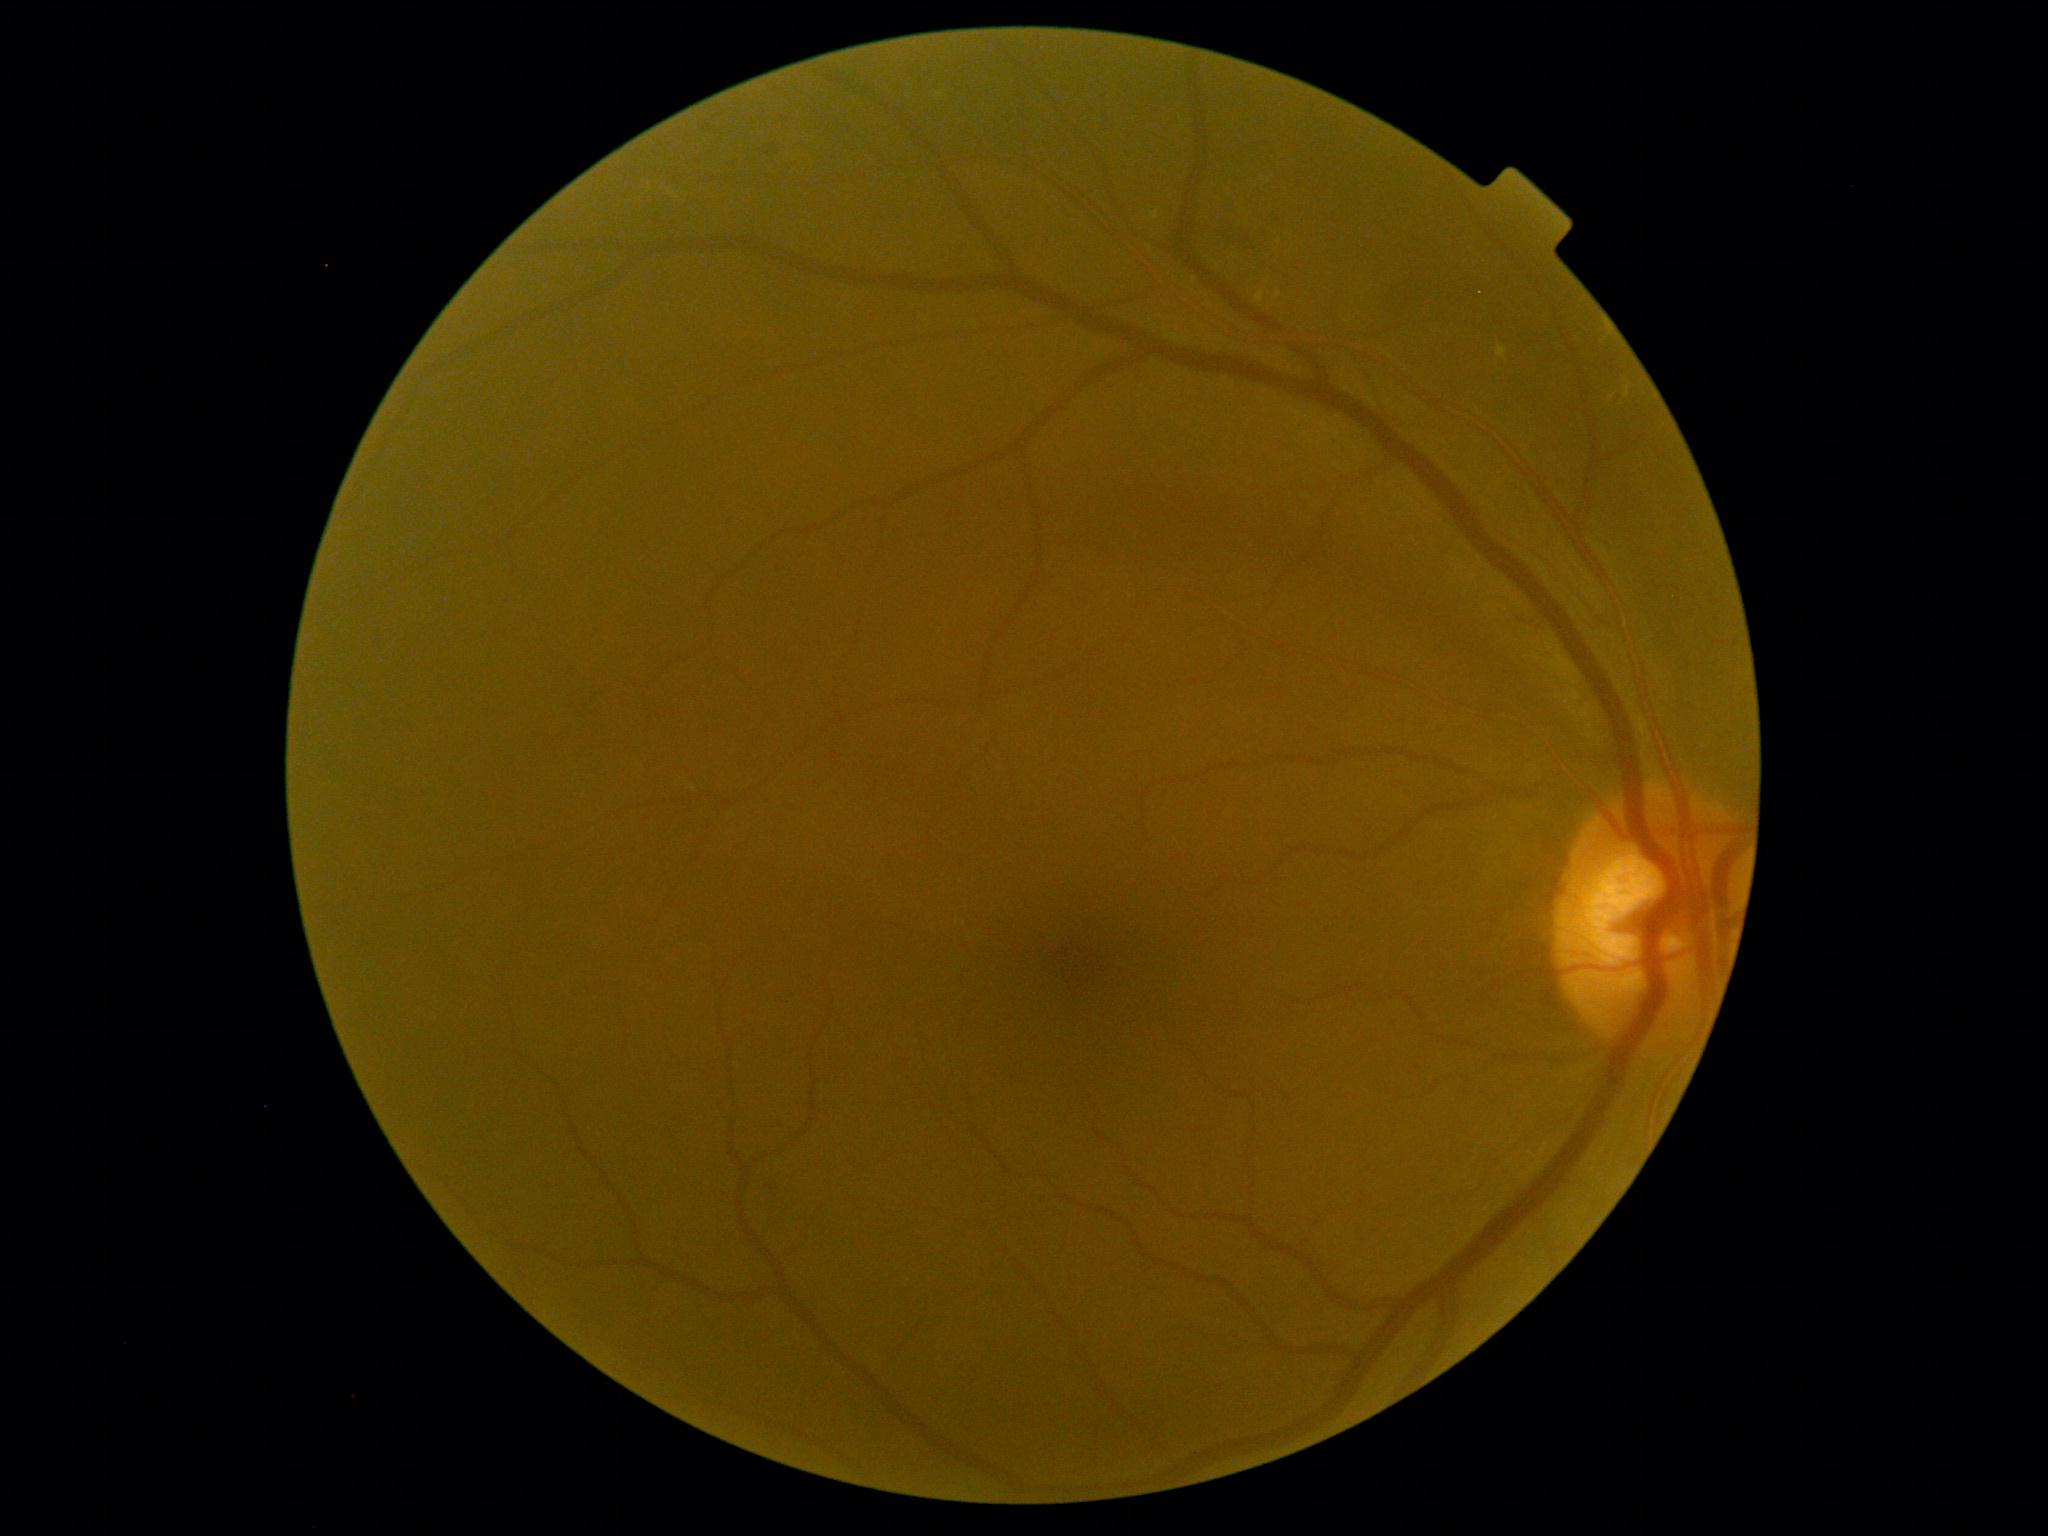
DR stage is 2.